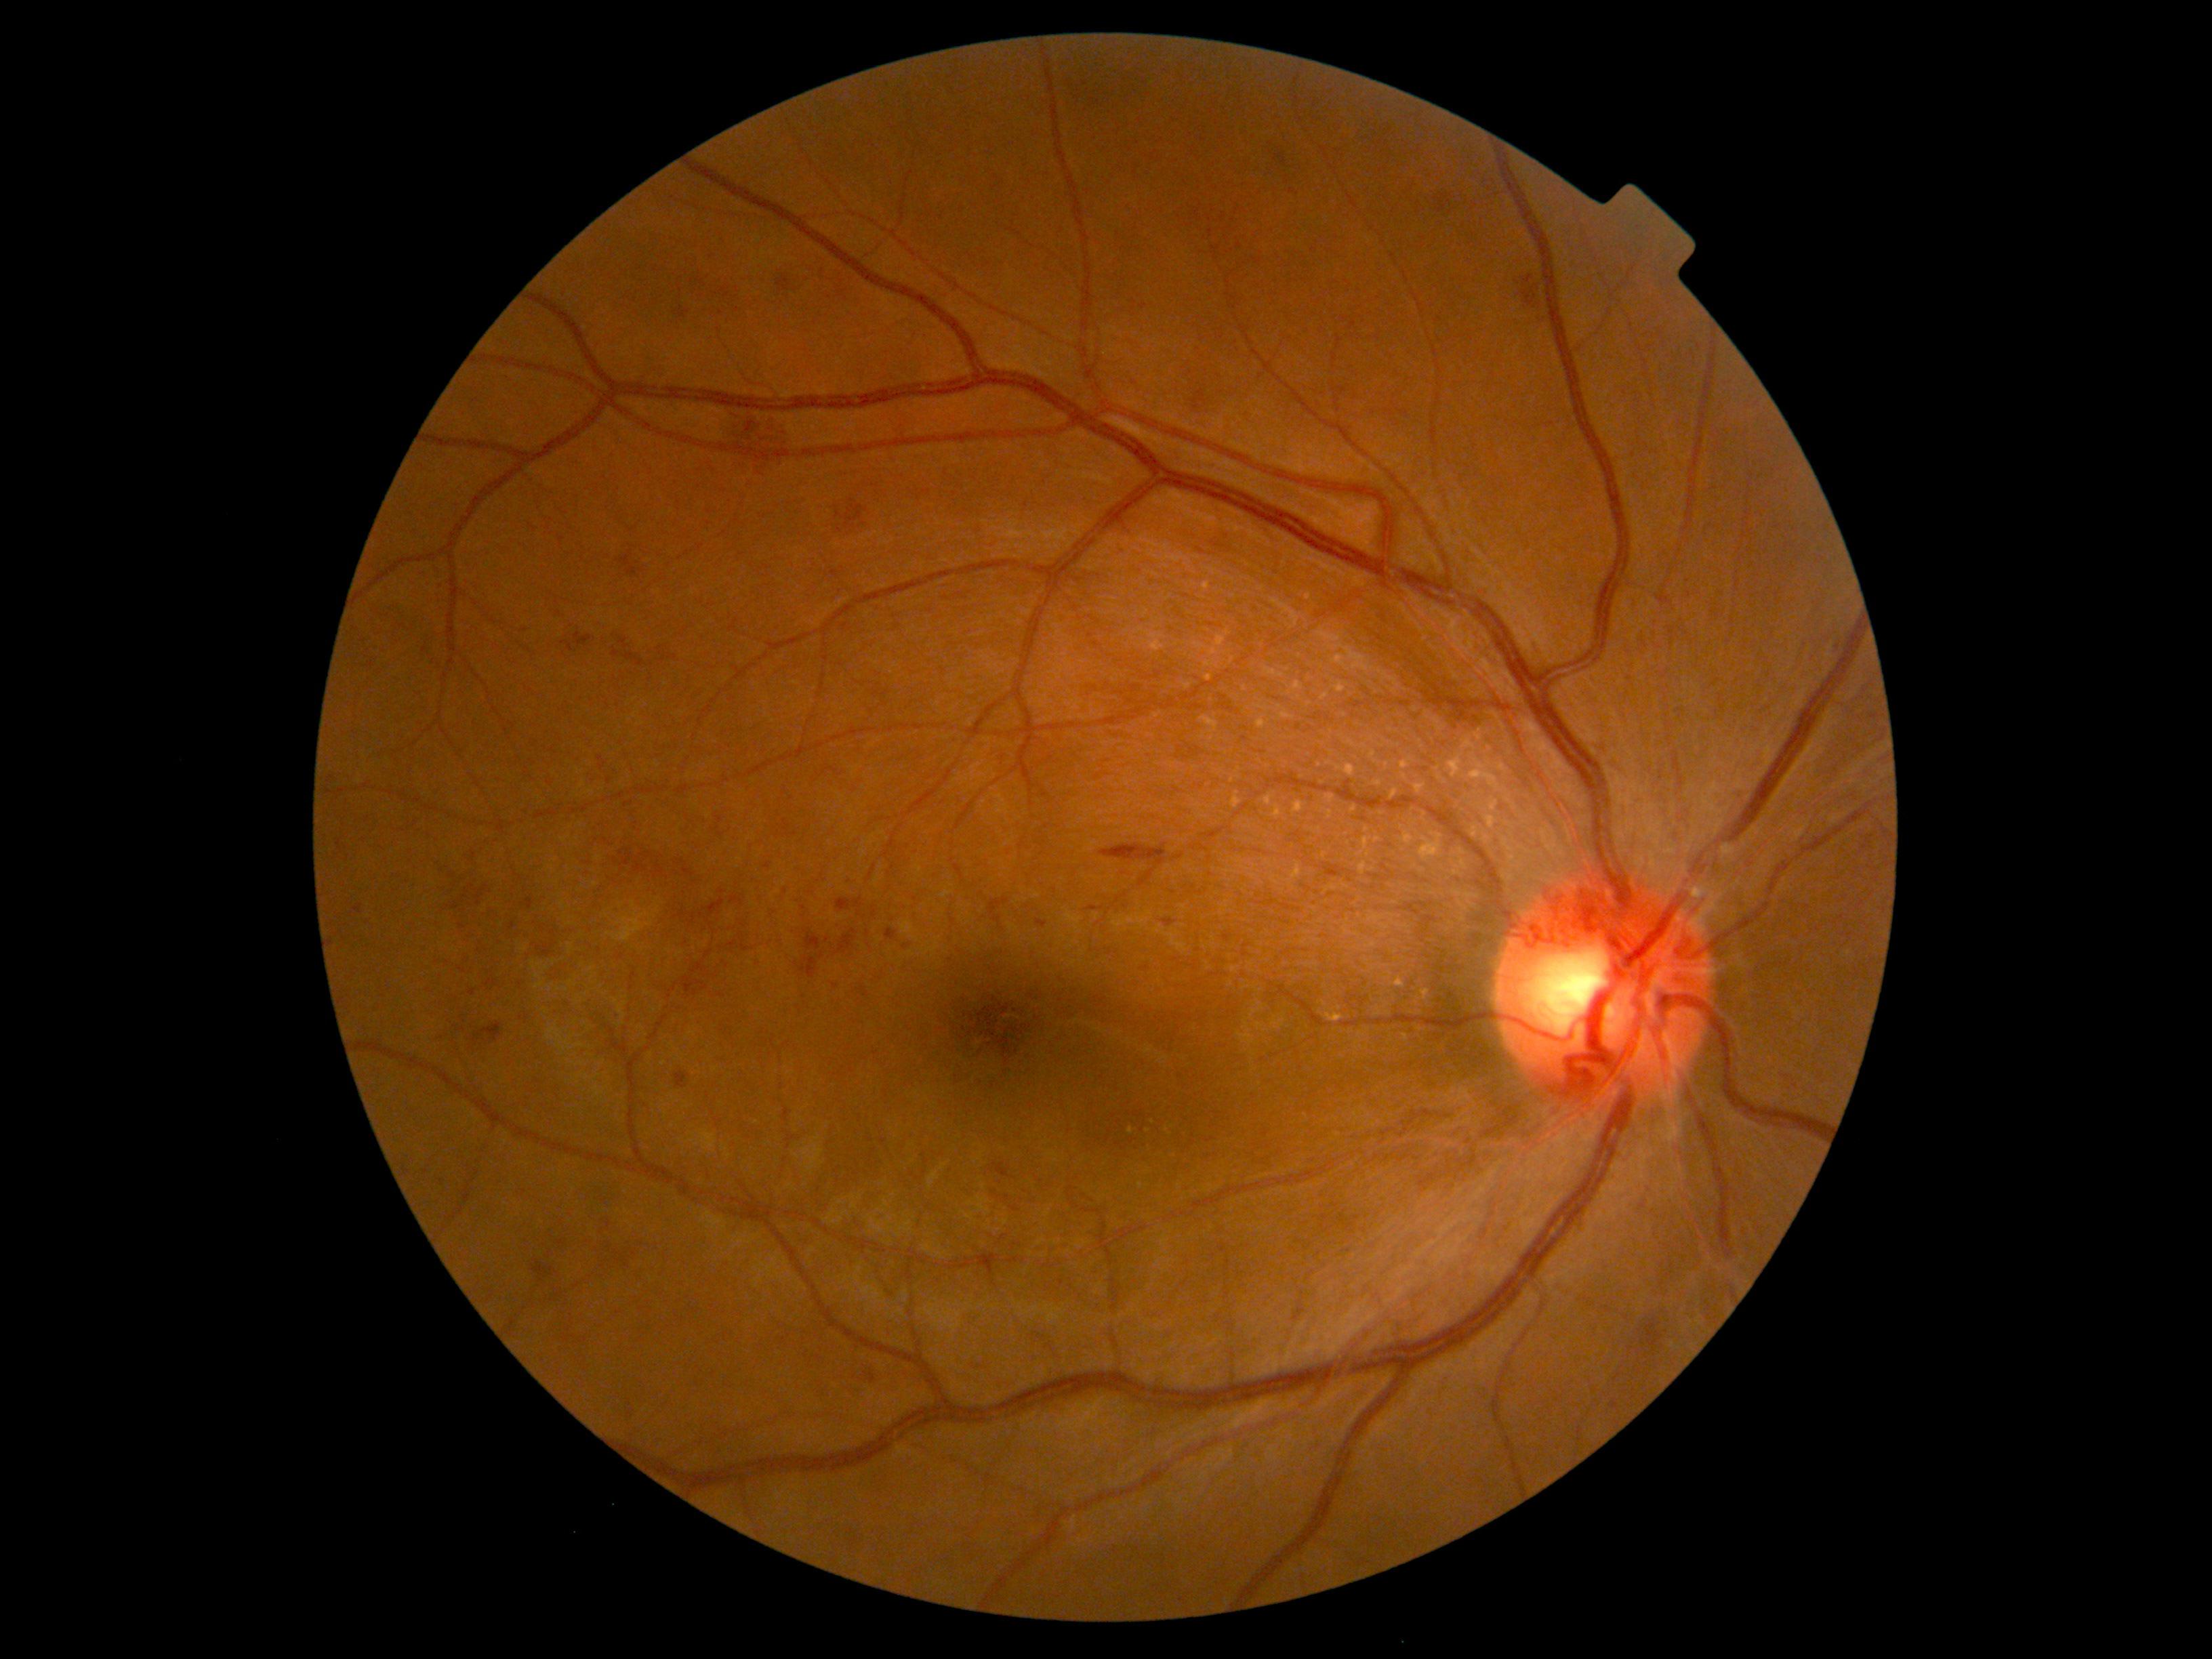

Diabetic retinopathy (DR): grade 2 (moderate NPDR)
A subset of detected lesions:
• hemorrhages (HEs) (subset): {"x1": 1132, "y1": 302, "x2": 1138, "y2": 310}, {"x1": 573, "y1": 632, "x2": 594, "y2": 647}, {"x1": 628, "y1": 1409, "x2": 635, "y2": 1417}, {"x1": 837, "y1": 898, "x2": 864, "y2": 913}, {"x1": 836, "y1": 929, "x2": 857, "y2": 955}, {"x1": 823, "y1": 766, "x2": 837, "y2": 775}, {"x1": 354, "y1": 905, "x2": 364, "y2": 914}, {"x1": 845, "y1": 876, "x2": 860, "y2": 887}, {"x1": 1610, "y1": 1402, "x2": 1619, "y2": 1410}, {"x1": 1161, "y1": 918, "x2": 1176, "y2": 928}, {"x1": 476, "y1": 884, "x2": 489, "y2": 906}, {"x1": 1517, "y1": 272, "x2": 1542, "y2": 318}
• Small HEs near (559, 614), (660, 858), (828, 939), (608, 1224), (629, 1401)